Wide-field fundus photograph of an infant:
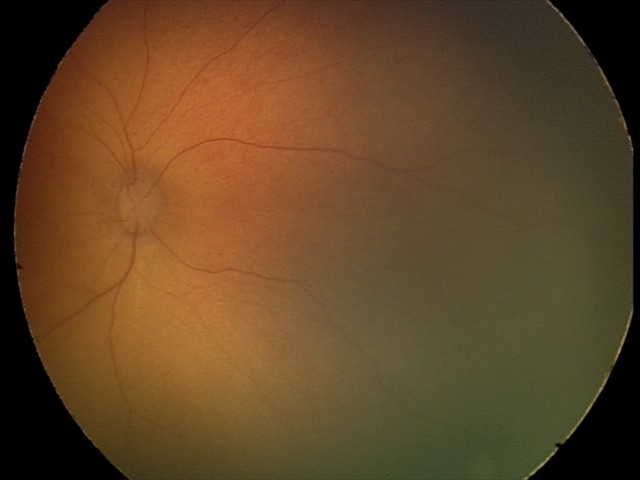
Screening examination with no abnormal retinal findings.